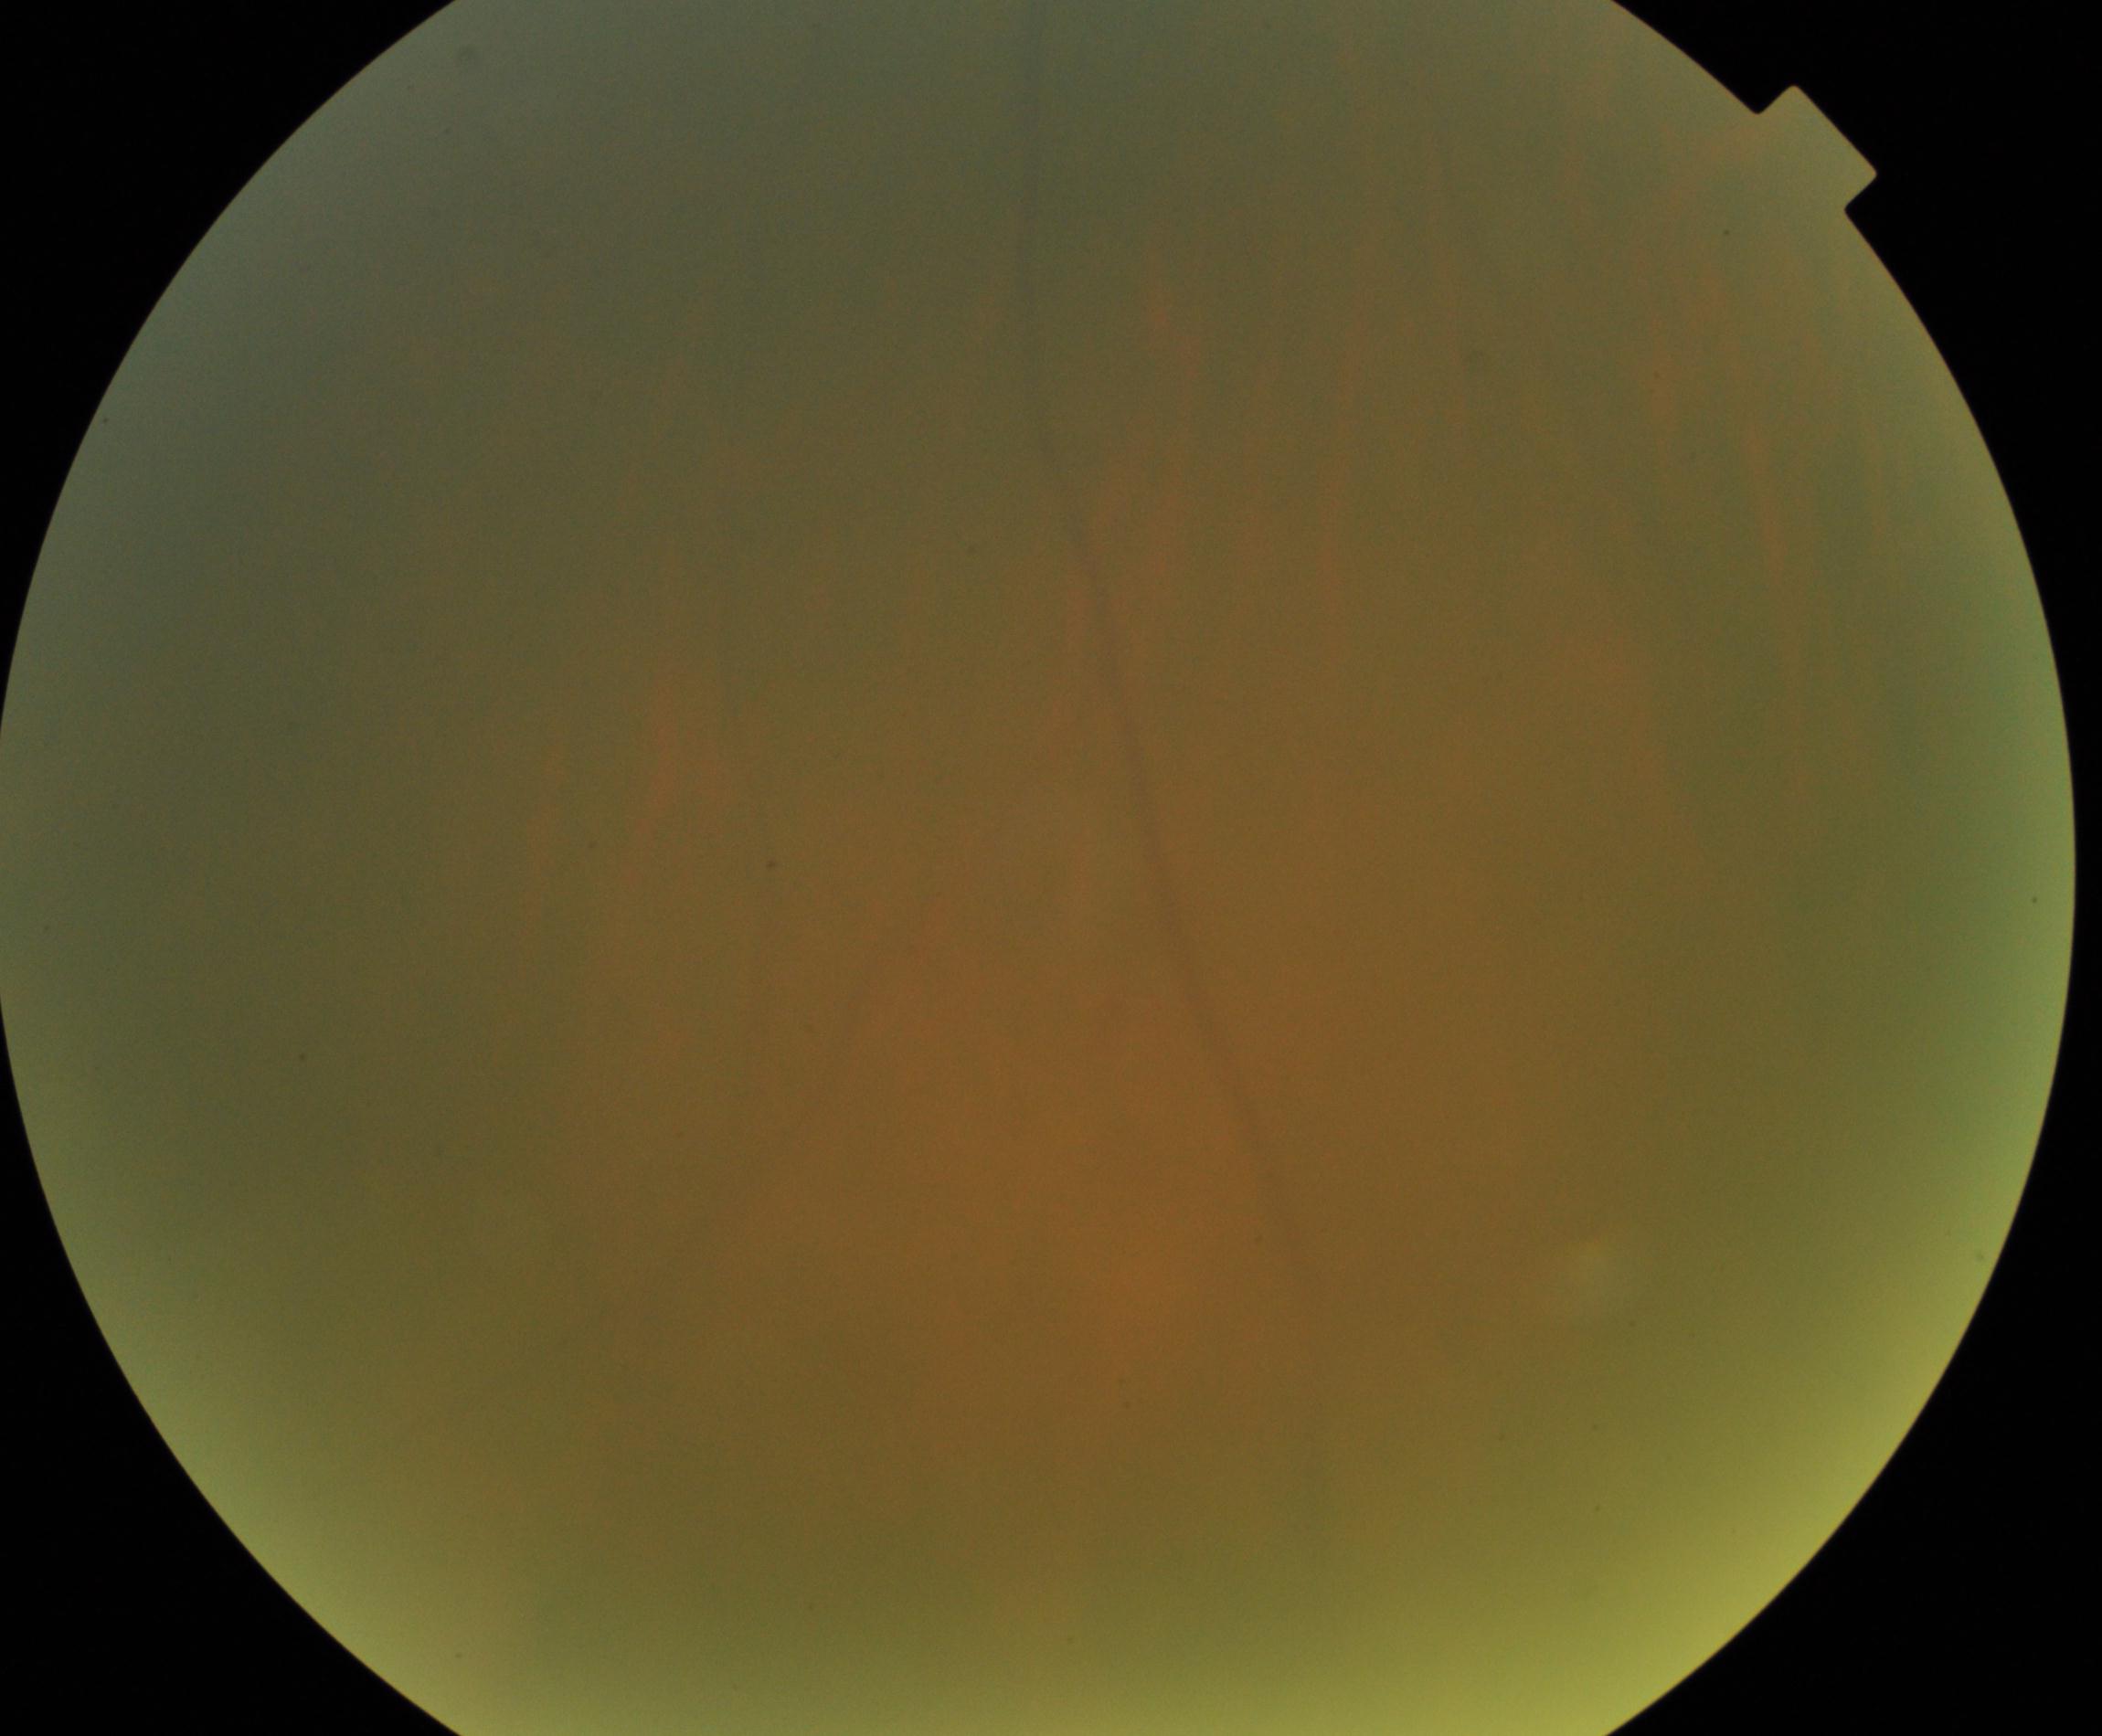
Quality: blurred, more than half the field obscured. Proliferative diabetic retinopathy: negative.